Modified Davis classification.
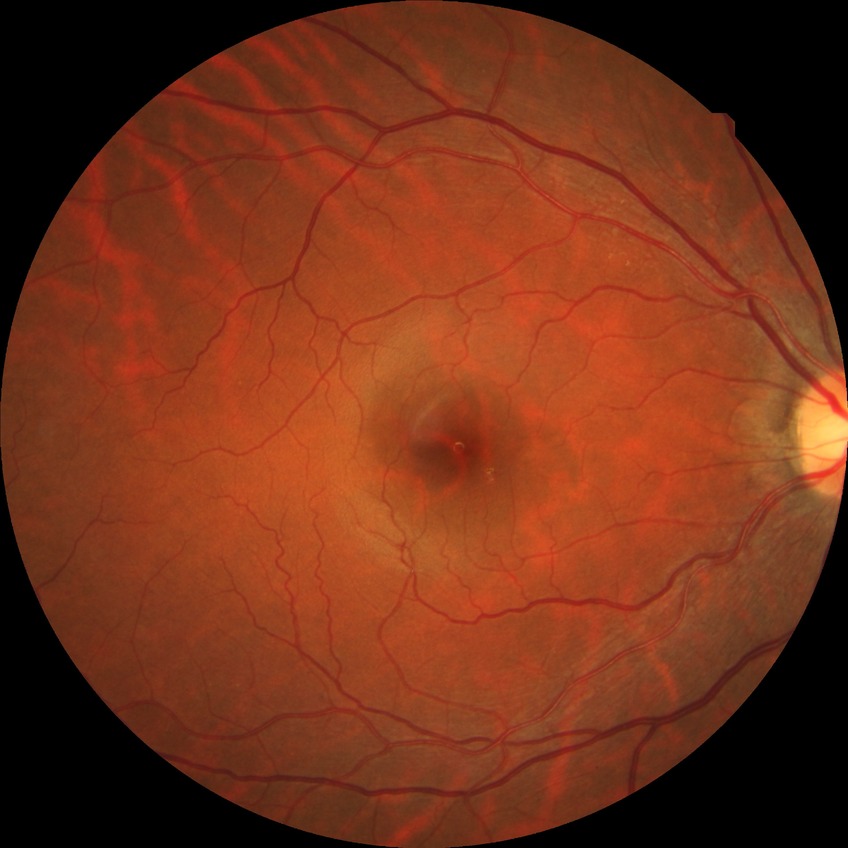
Diabetic retinopathy (DR) is no diabetic retinopathy (NDR).